Acquired with a NIDEK AFC-230 · 45-degree field of view:
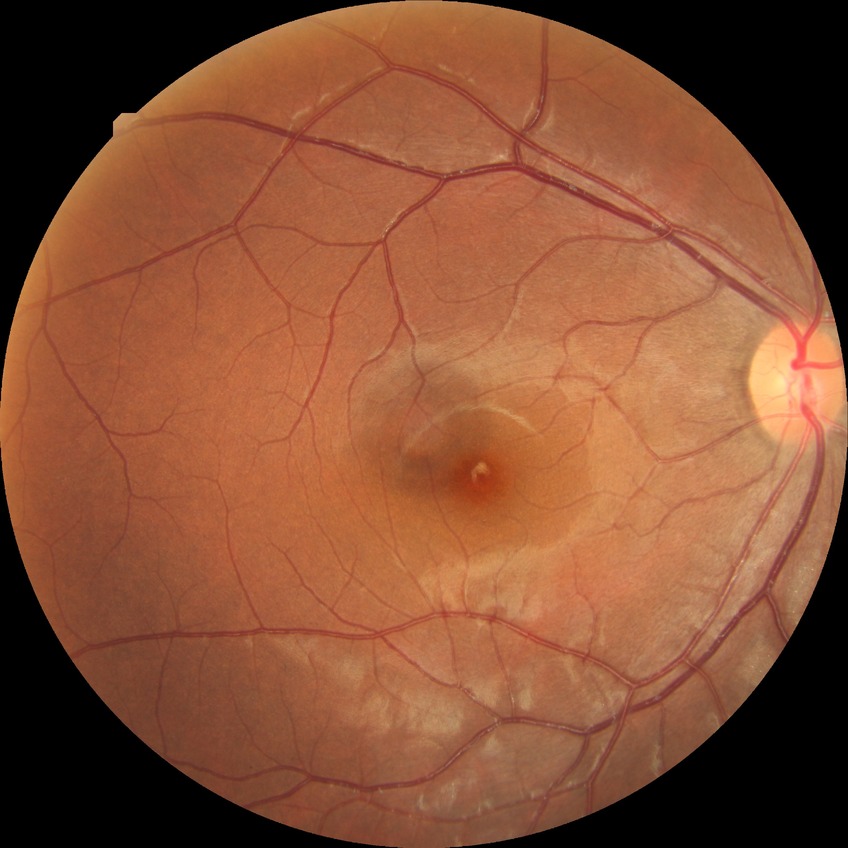
davis_grade: NDR (no diabetic retinopathy)